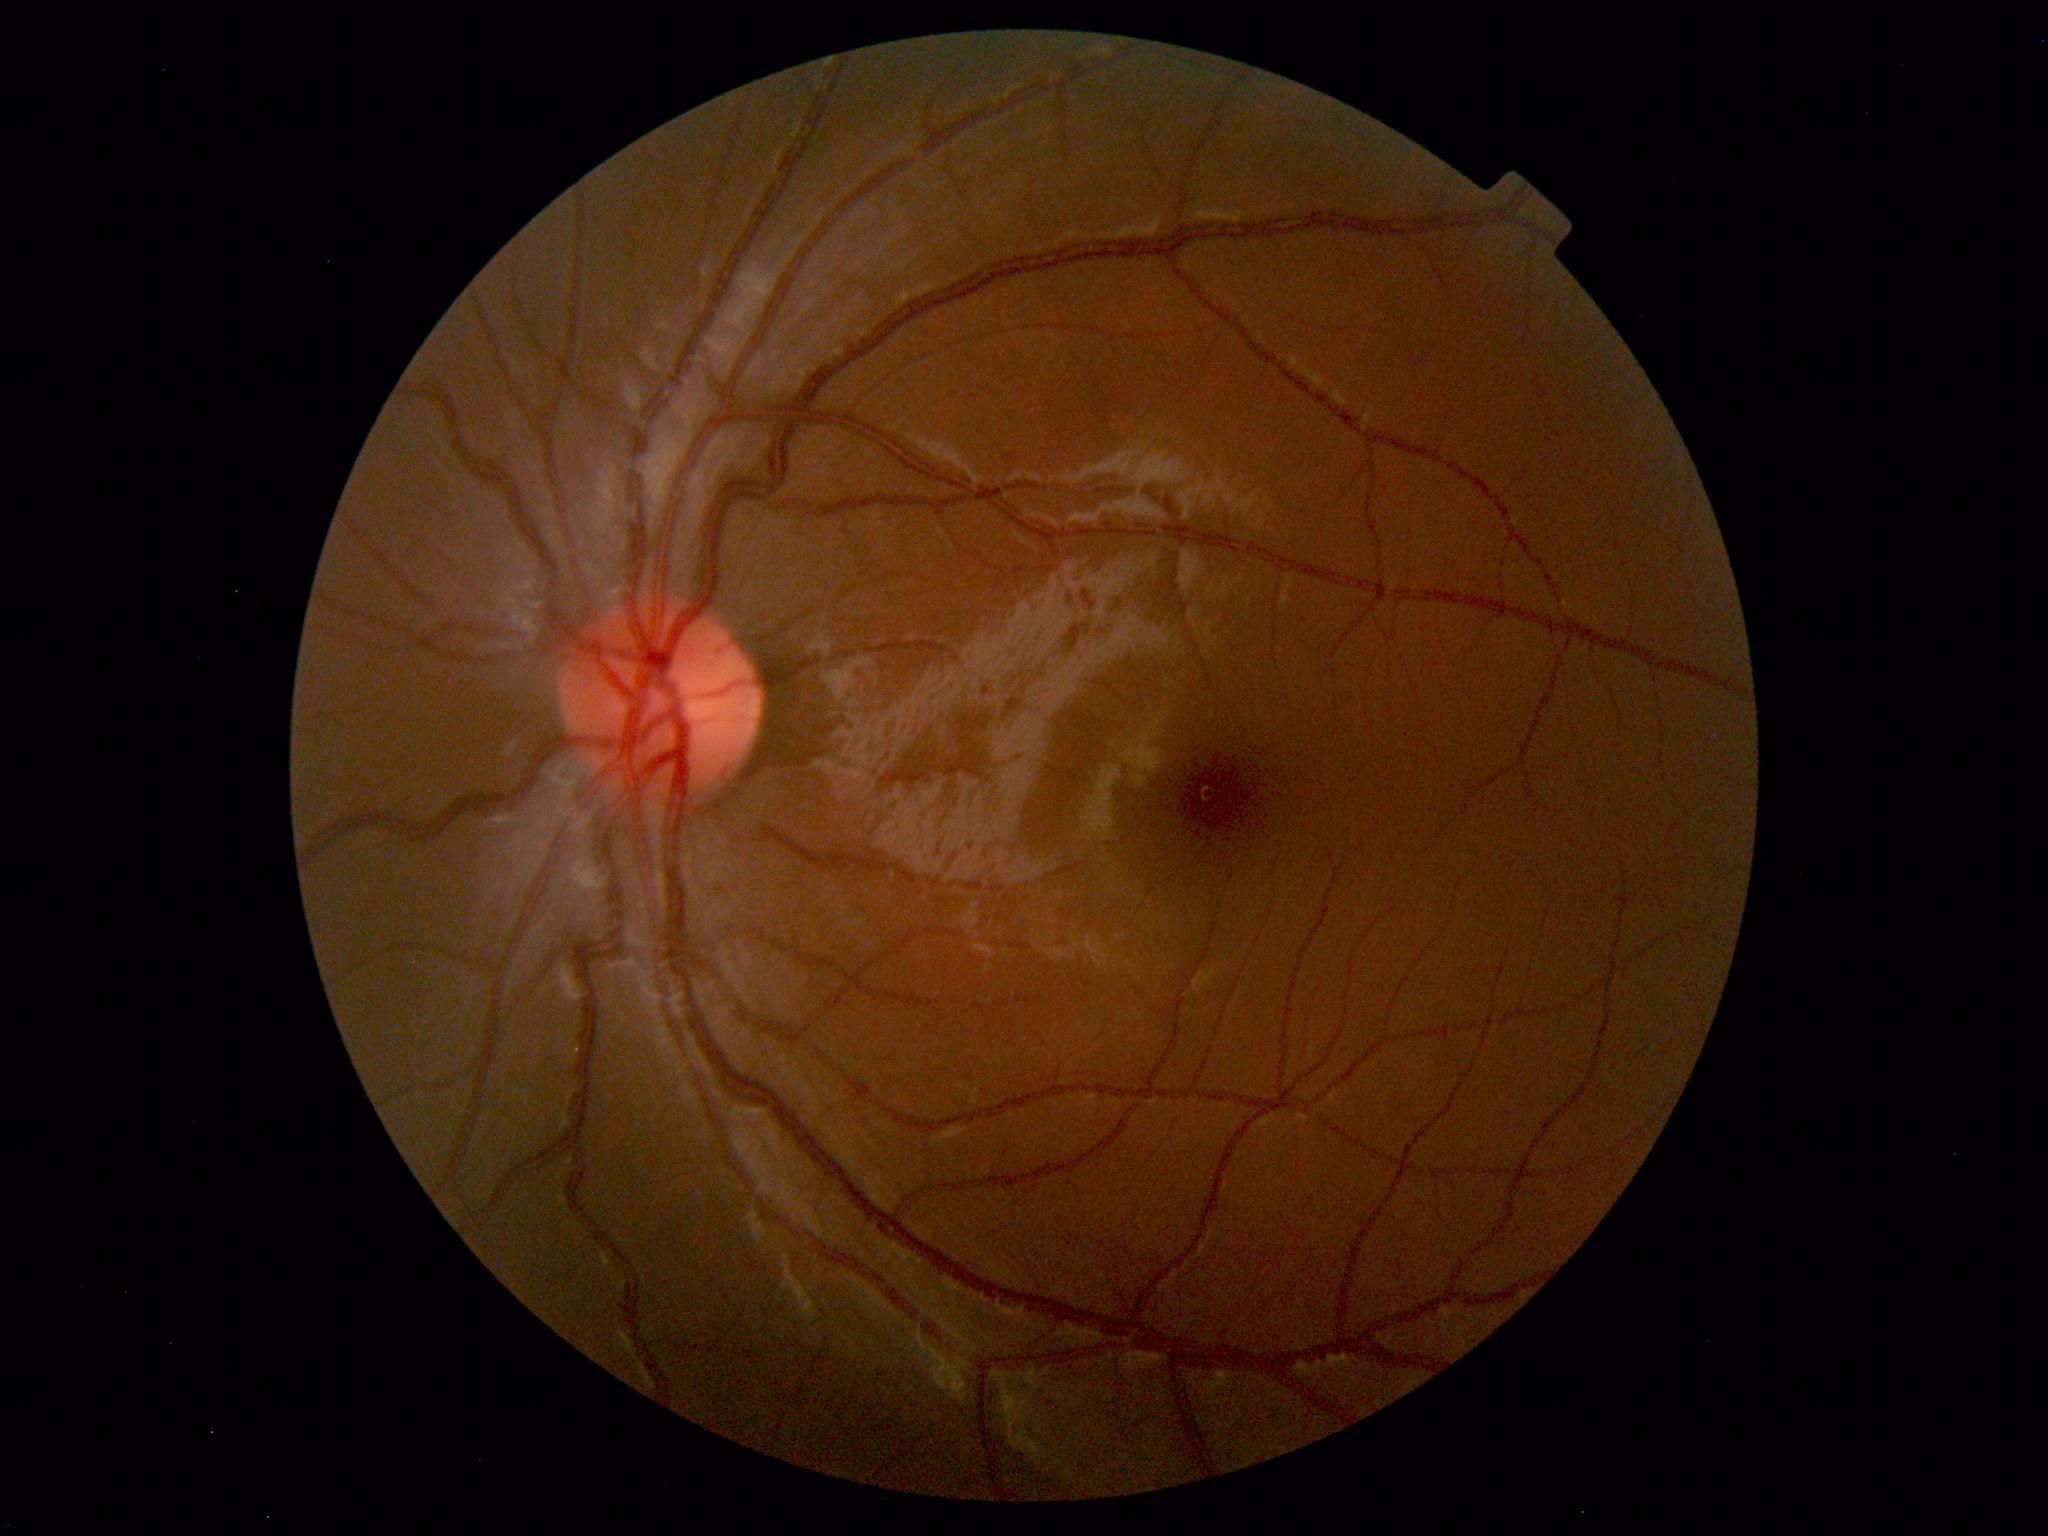
Diagnosis: normal.